Wide-field contact fundus photograph of an infant — 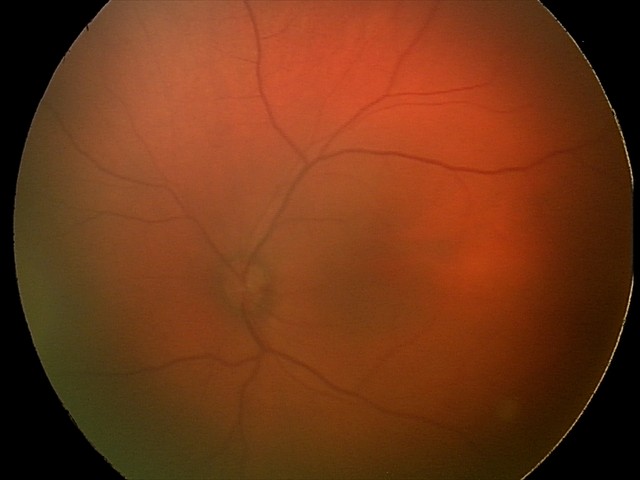
Impression = retinal hemorrhages.